Captured with the Natus RetCam Envision (130° field of view); 1440 x 1080 pixels; wide-field fundus photograph from neonatal ROP screening: 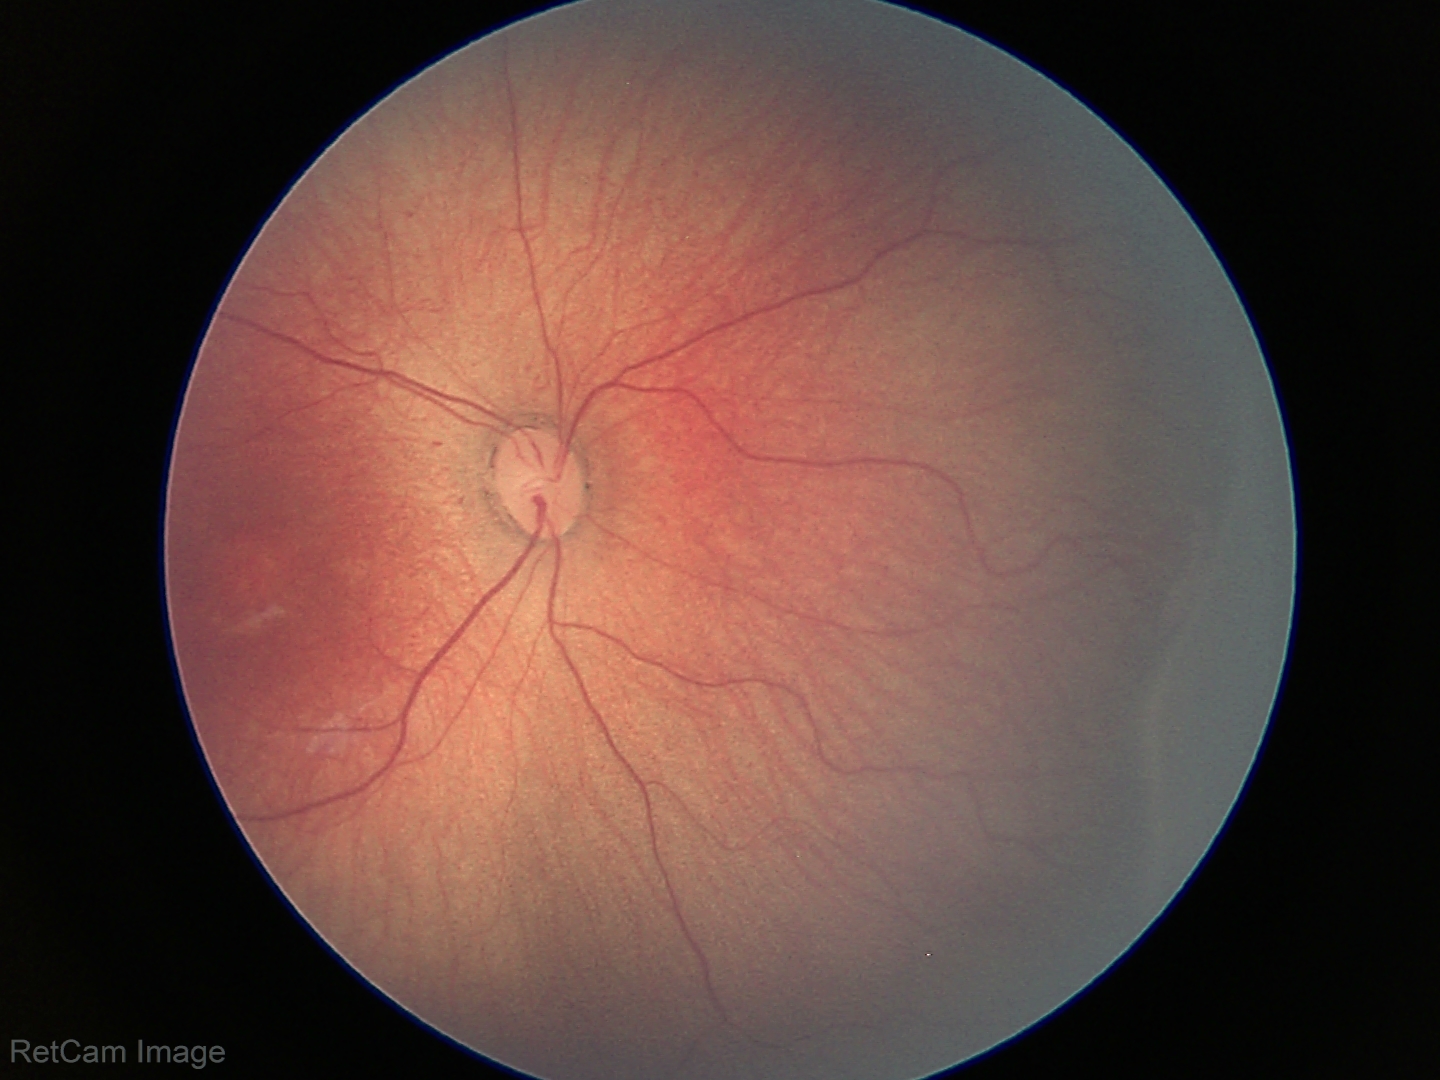

Series diagnosed as retinopathy of prematurity stage 2. Plus disease absent.